45-degree field of view — 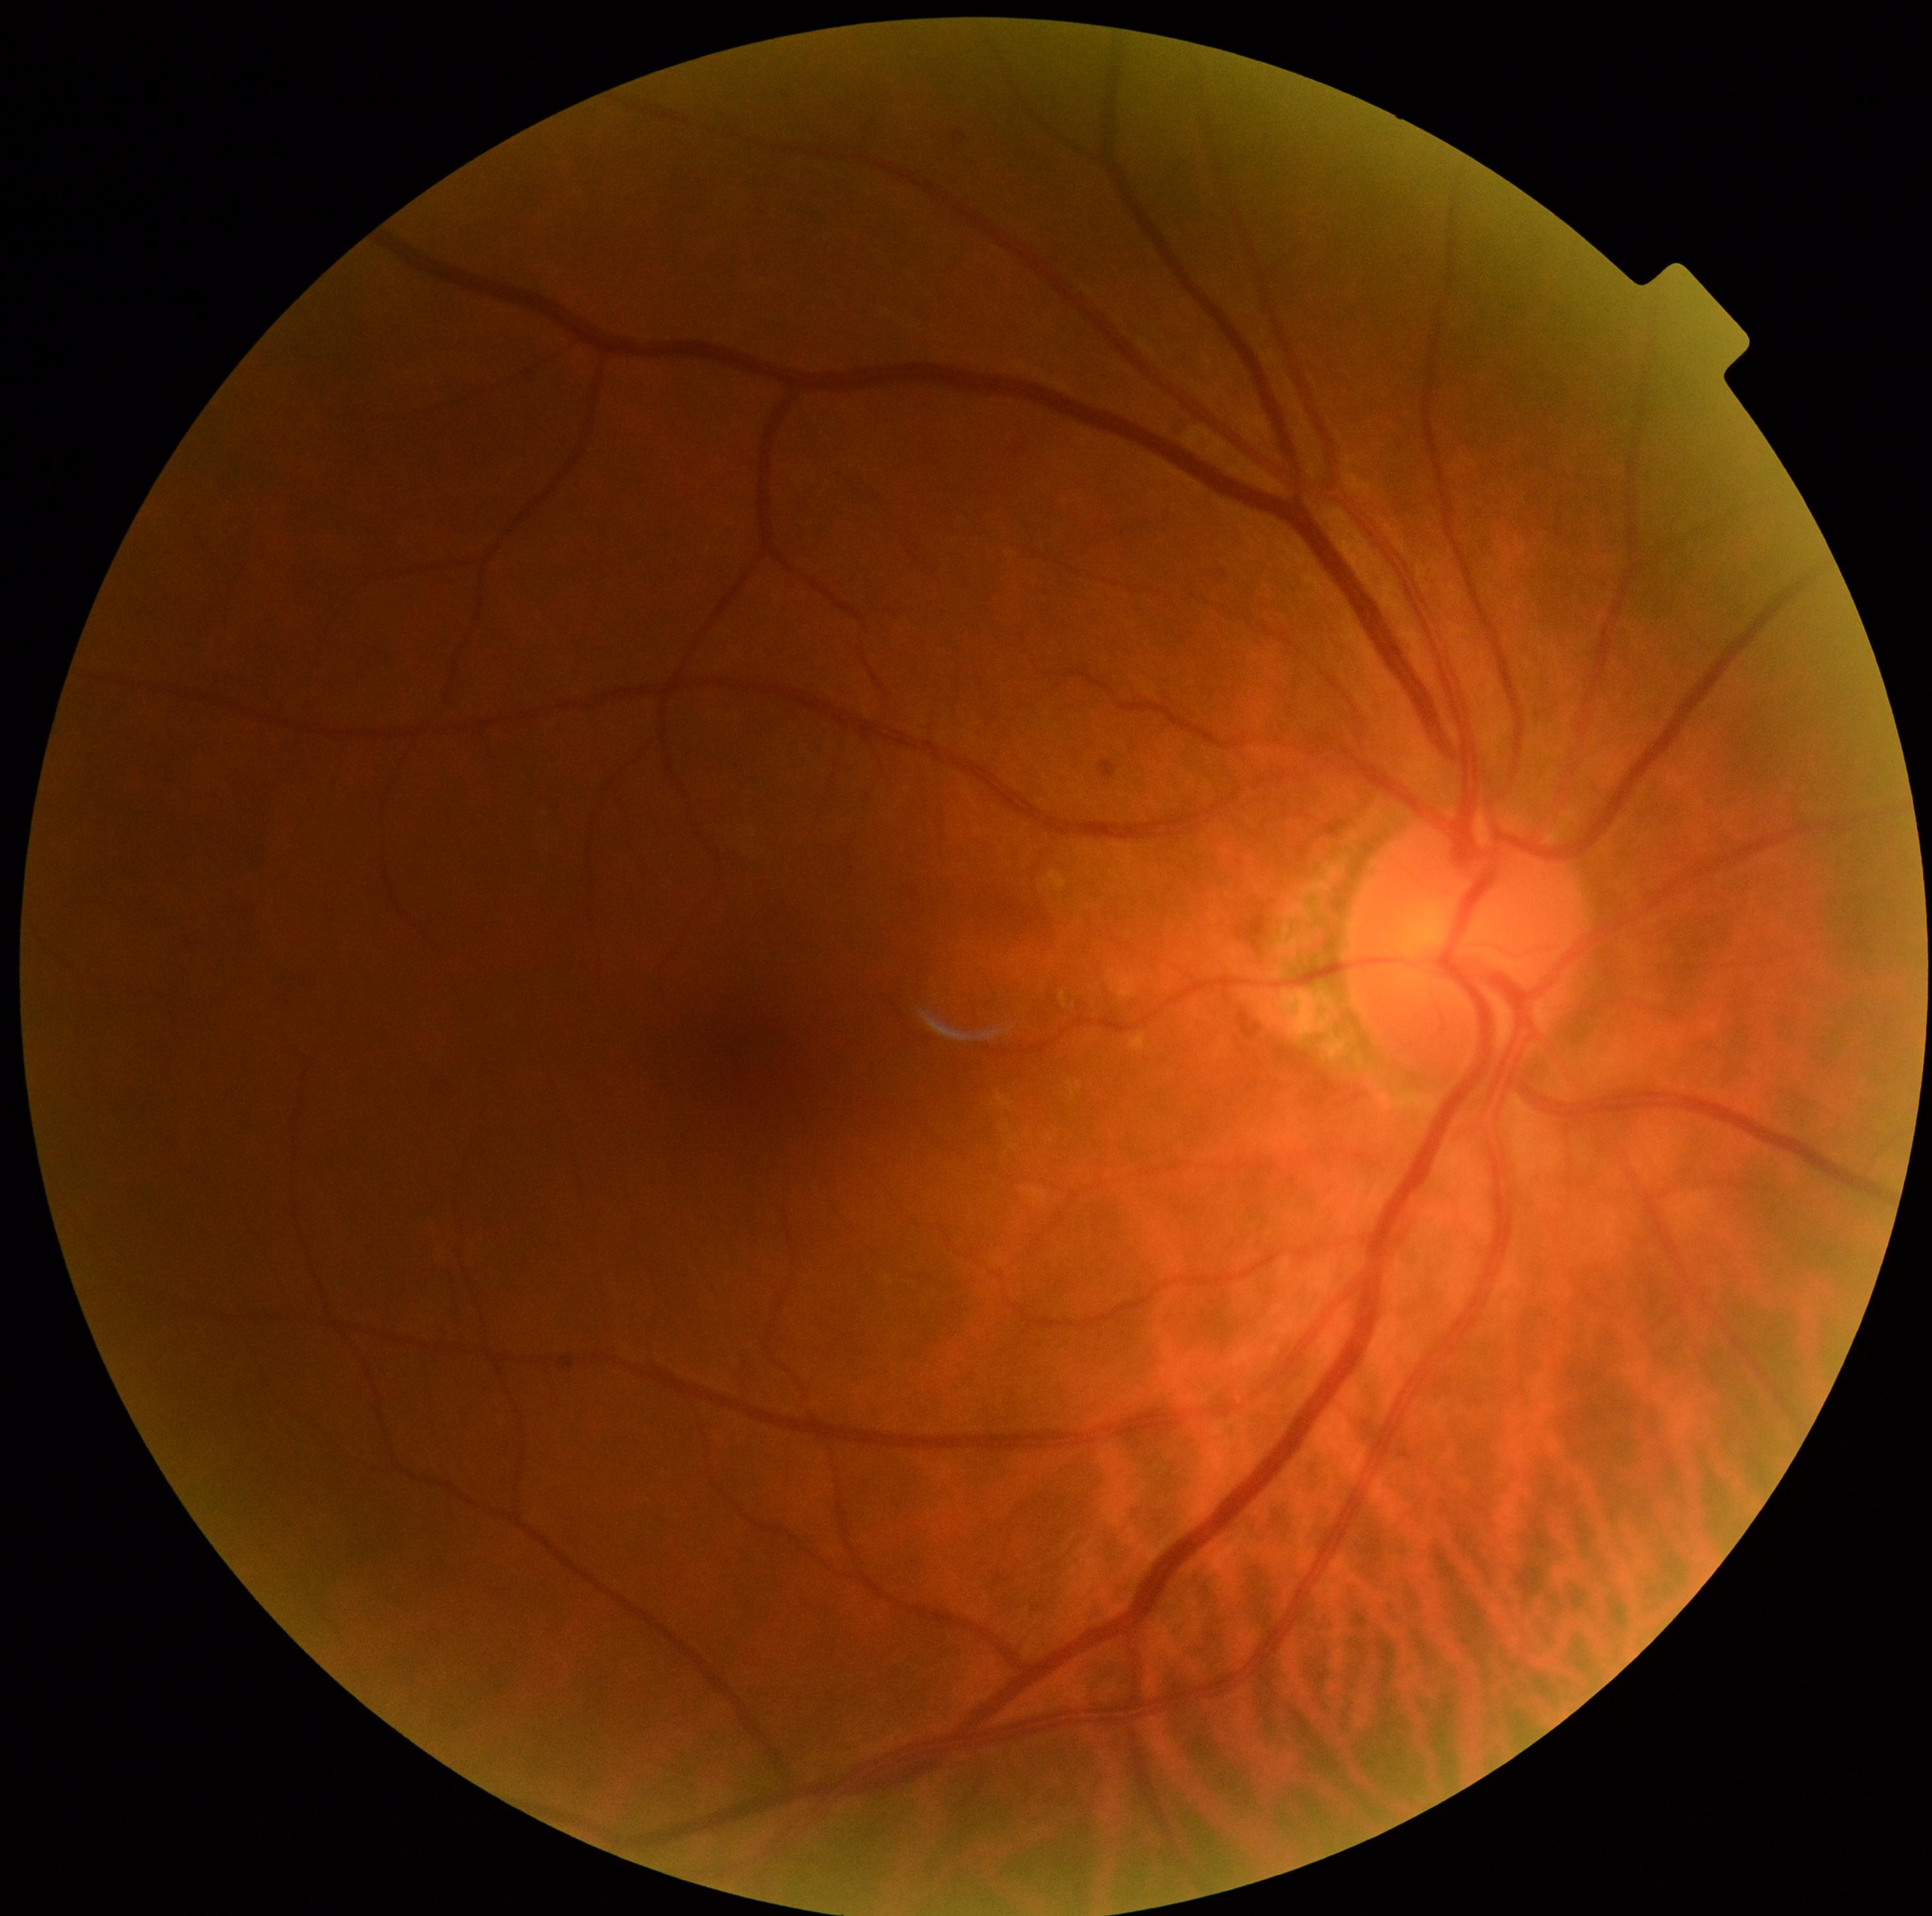
DR impression: no signs of DR, diabetic retinopathy (DR): no apparent diabetic retinopathy (grade 0).